Color fundus photograph. Captured on a Topcon TRC-50DX fundus camera. 50-degree field of view. Captured after pupil dilation.
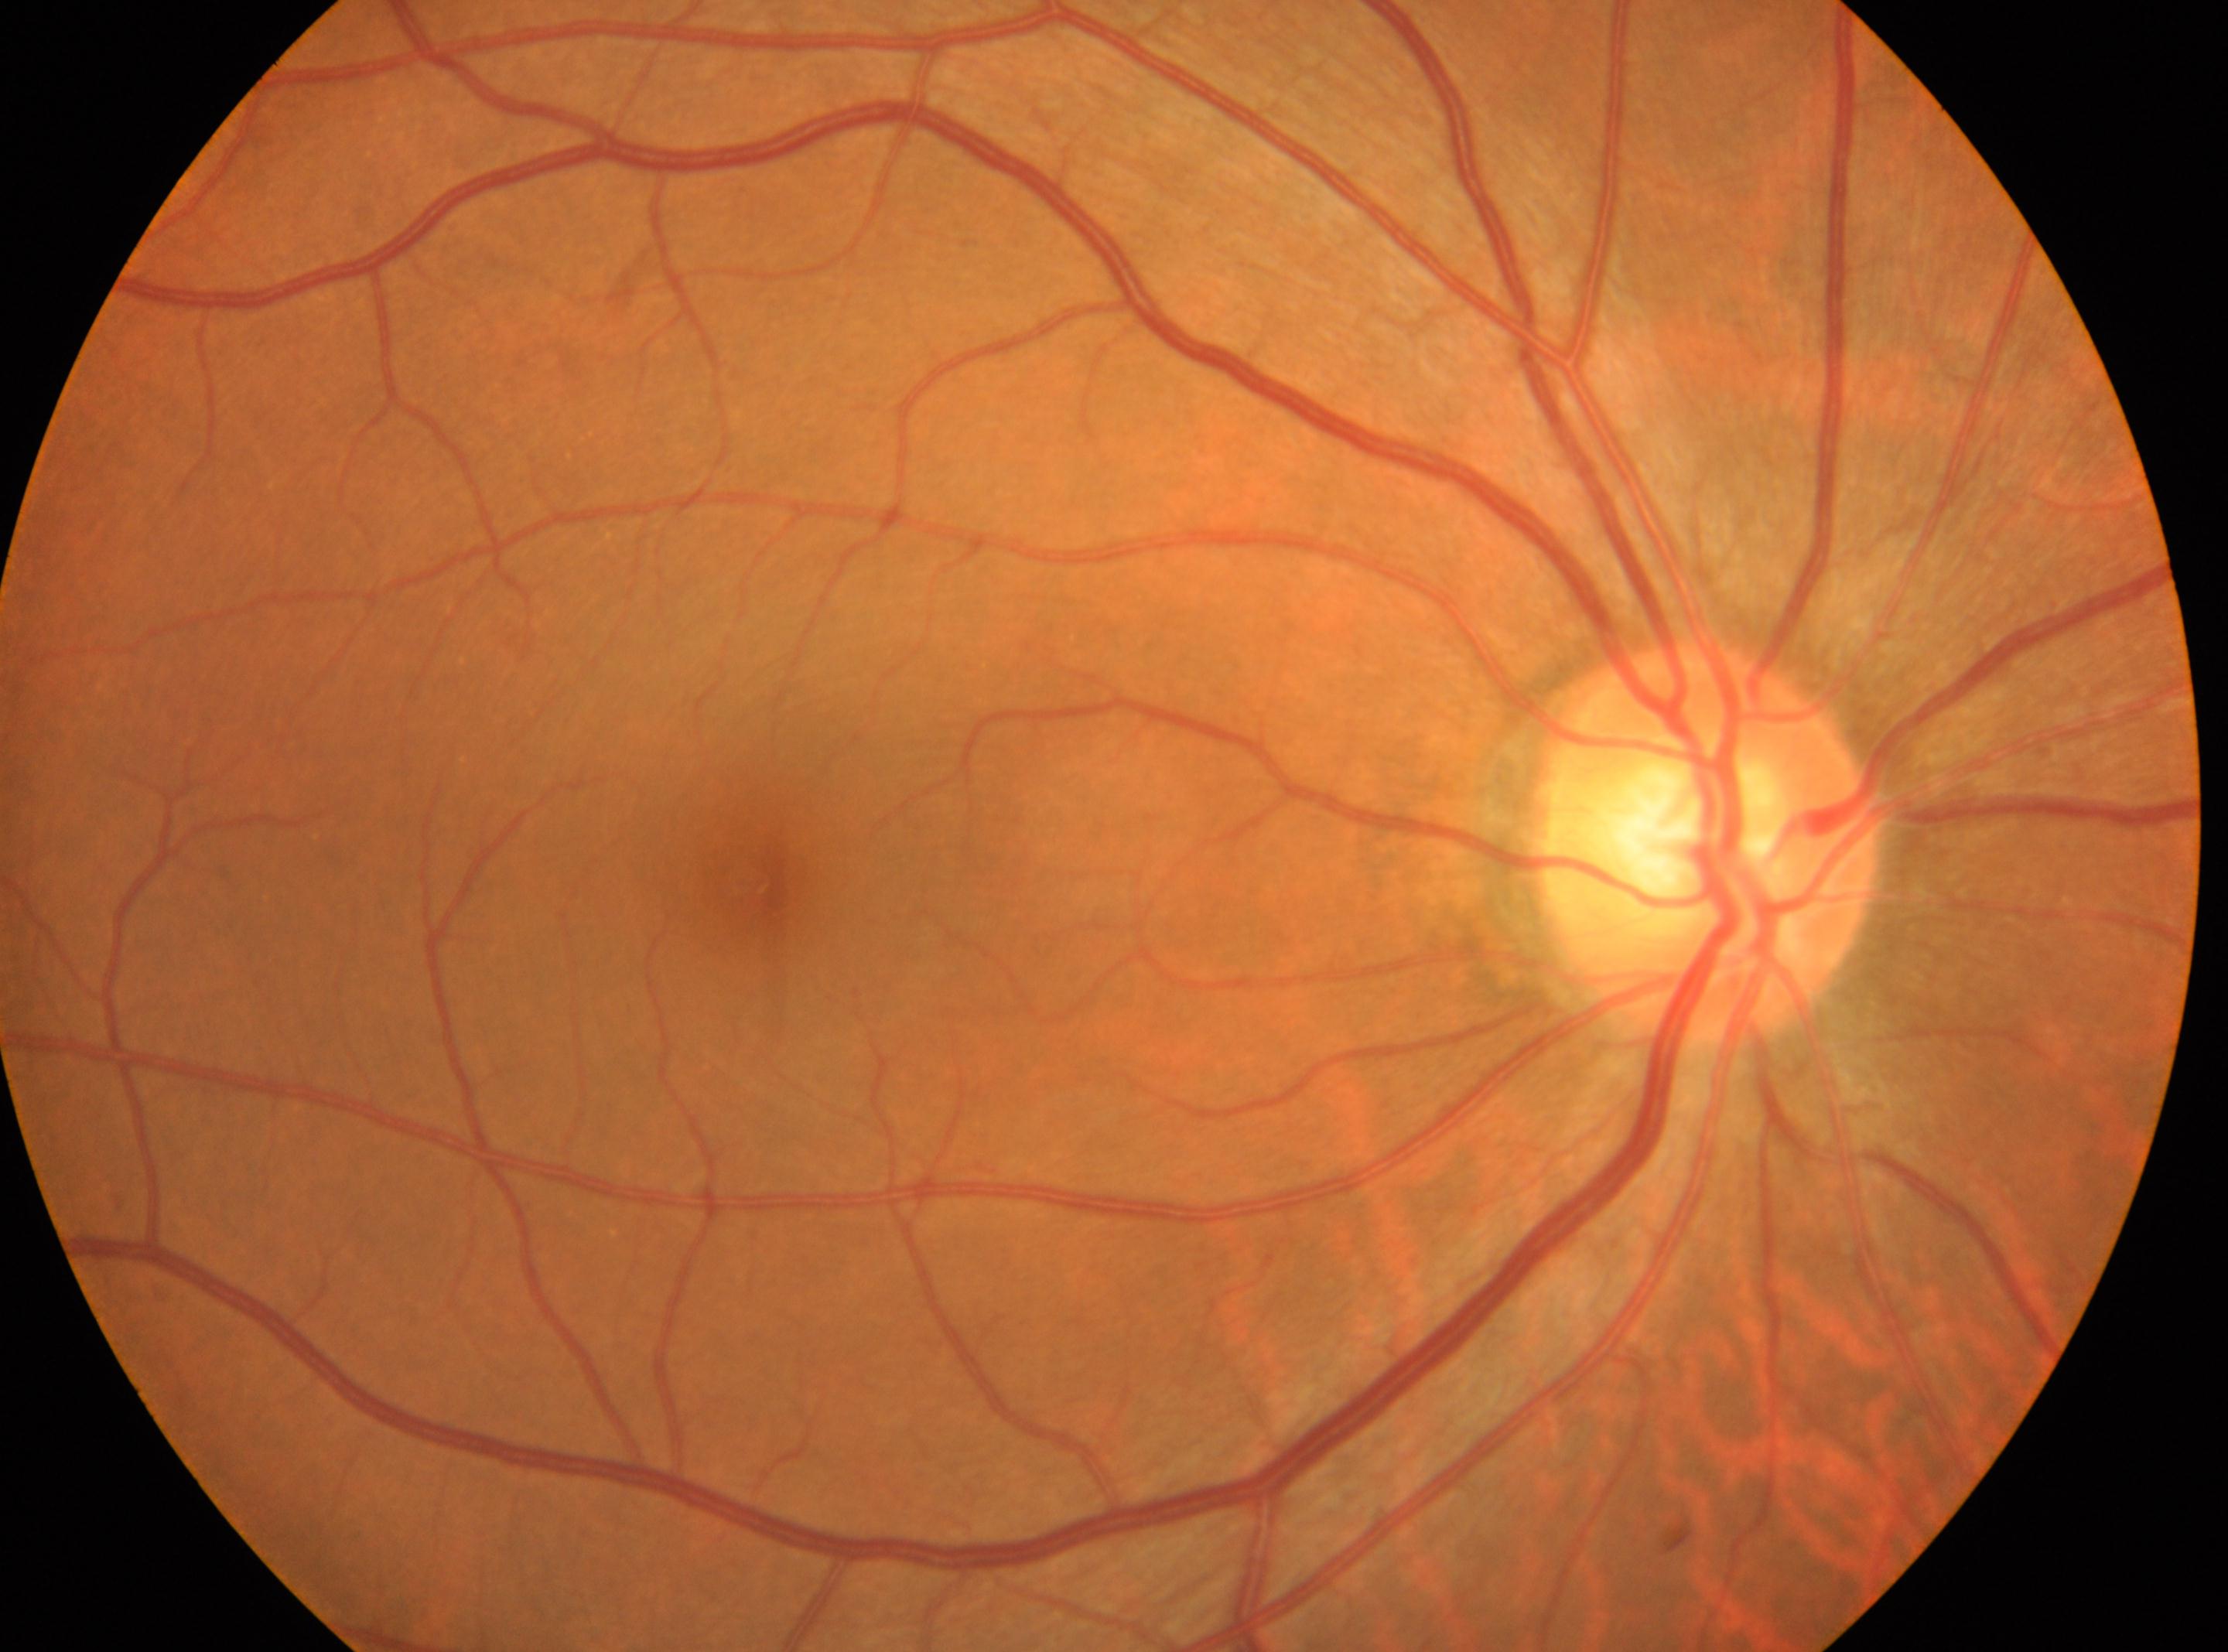
ONH = [1709, 841]
macula center = [749, 879]
DR severity = no apparent retinopathy (grade 0)
eye = OD